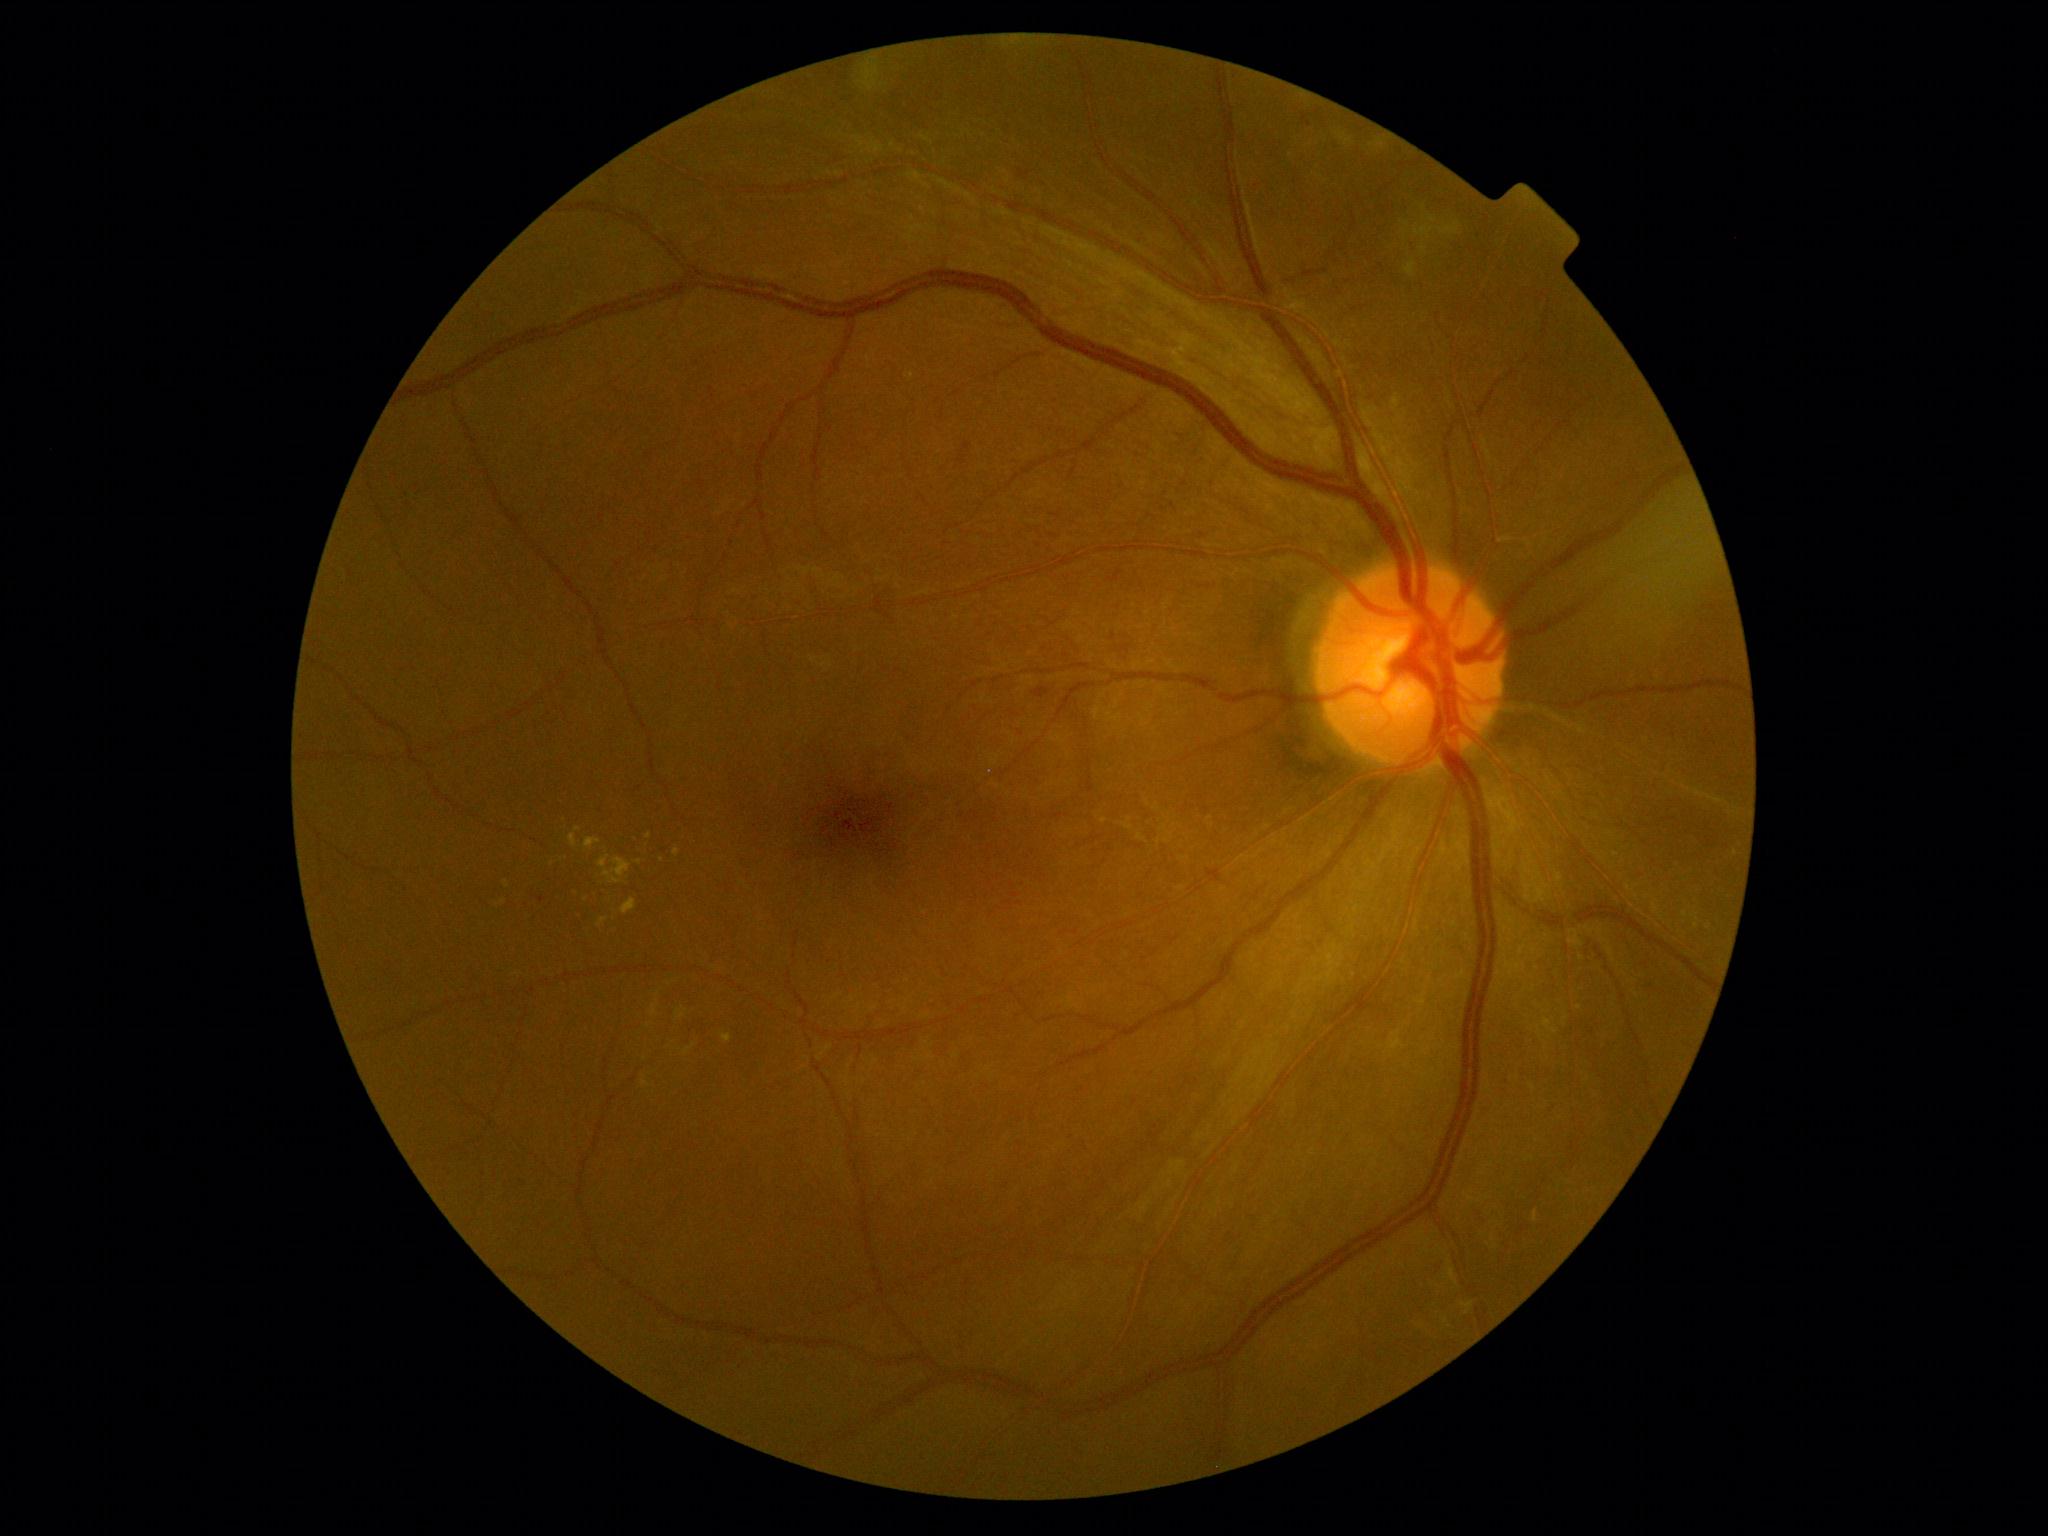
DR: 2.